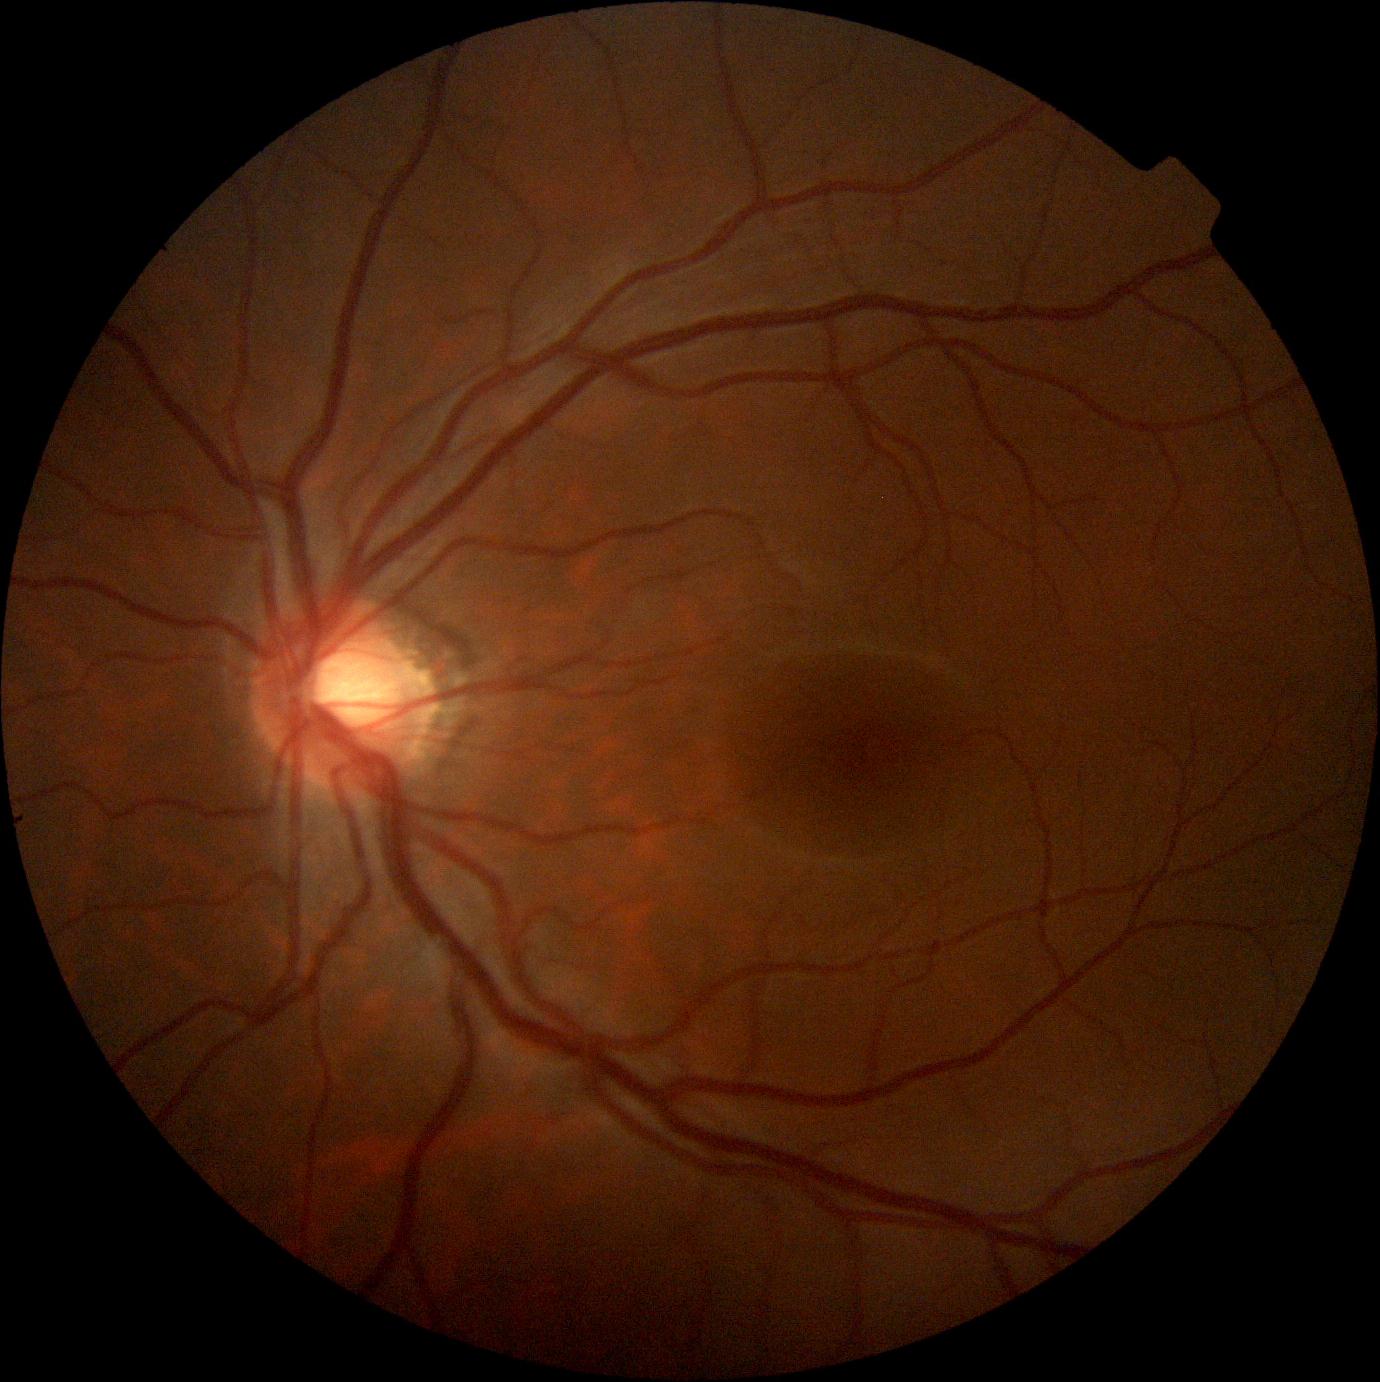
DR impression: negative for DR; DR: no apparent diabetic retinopathy (grade 0).